Image size 2048x1536
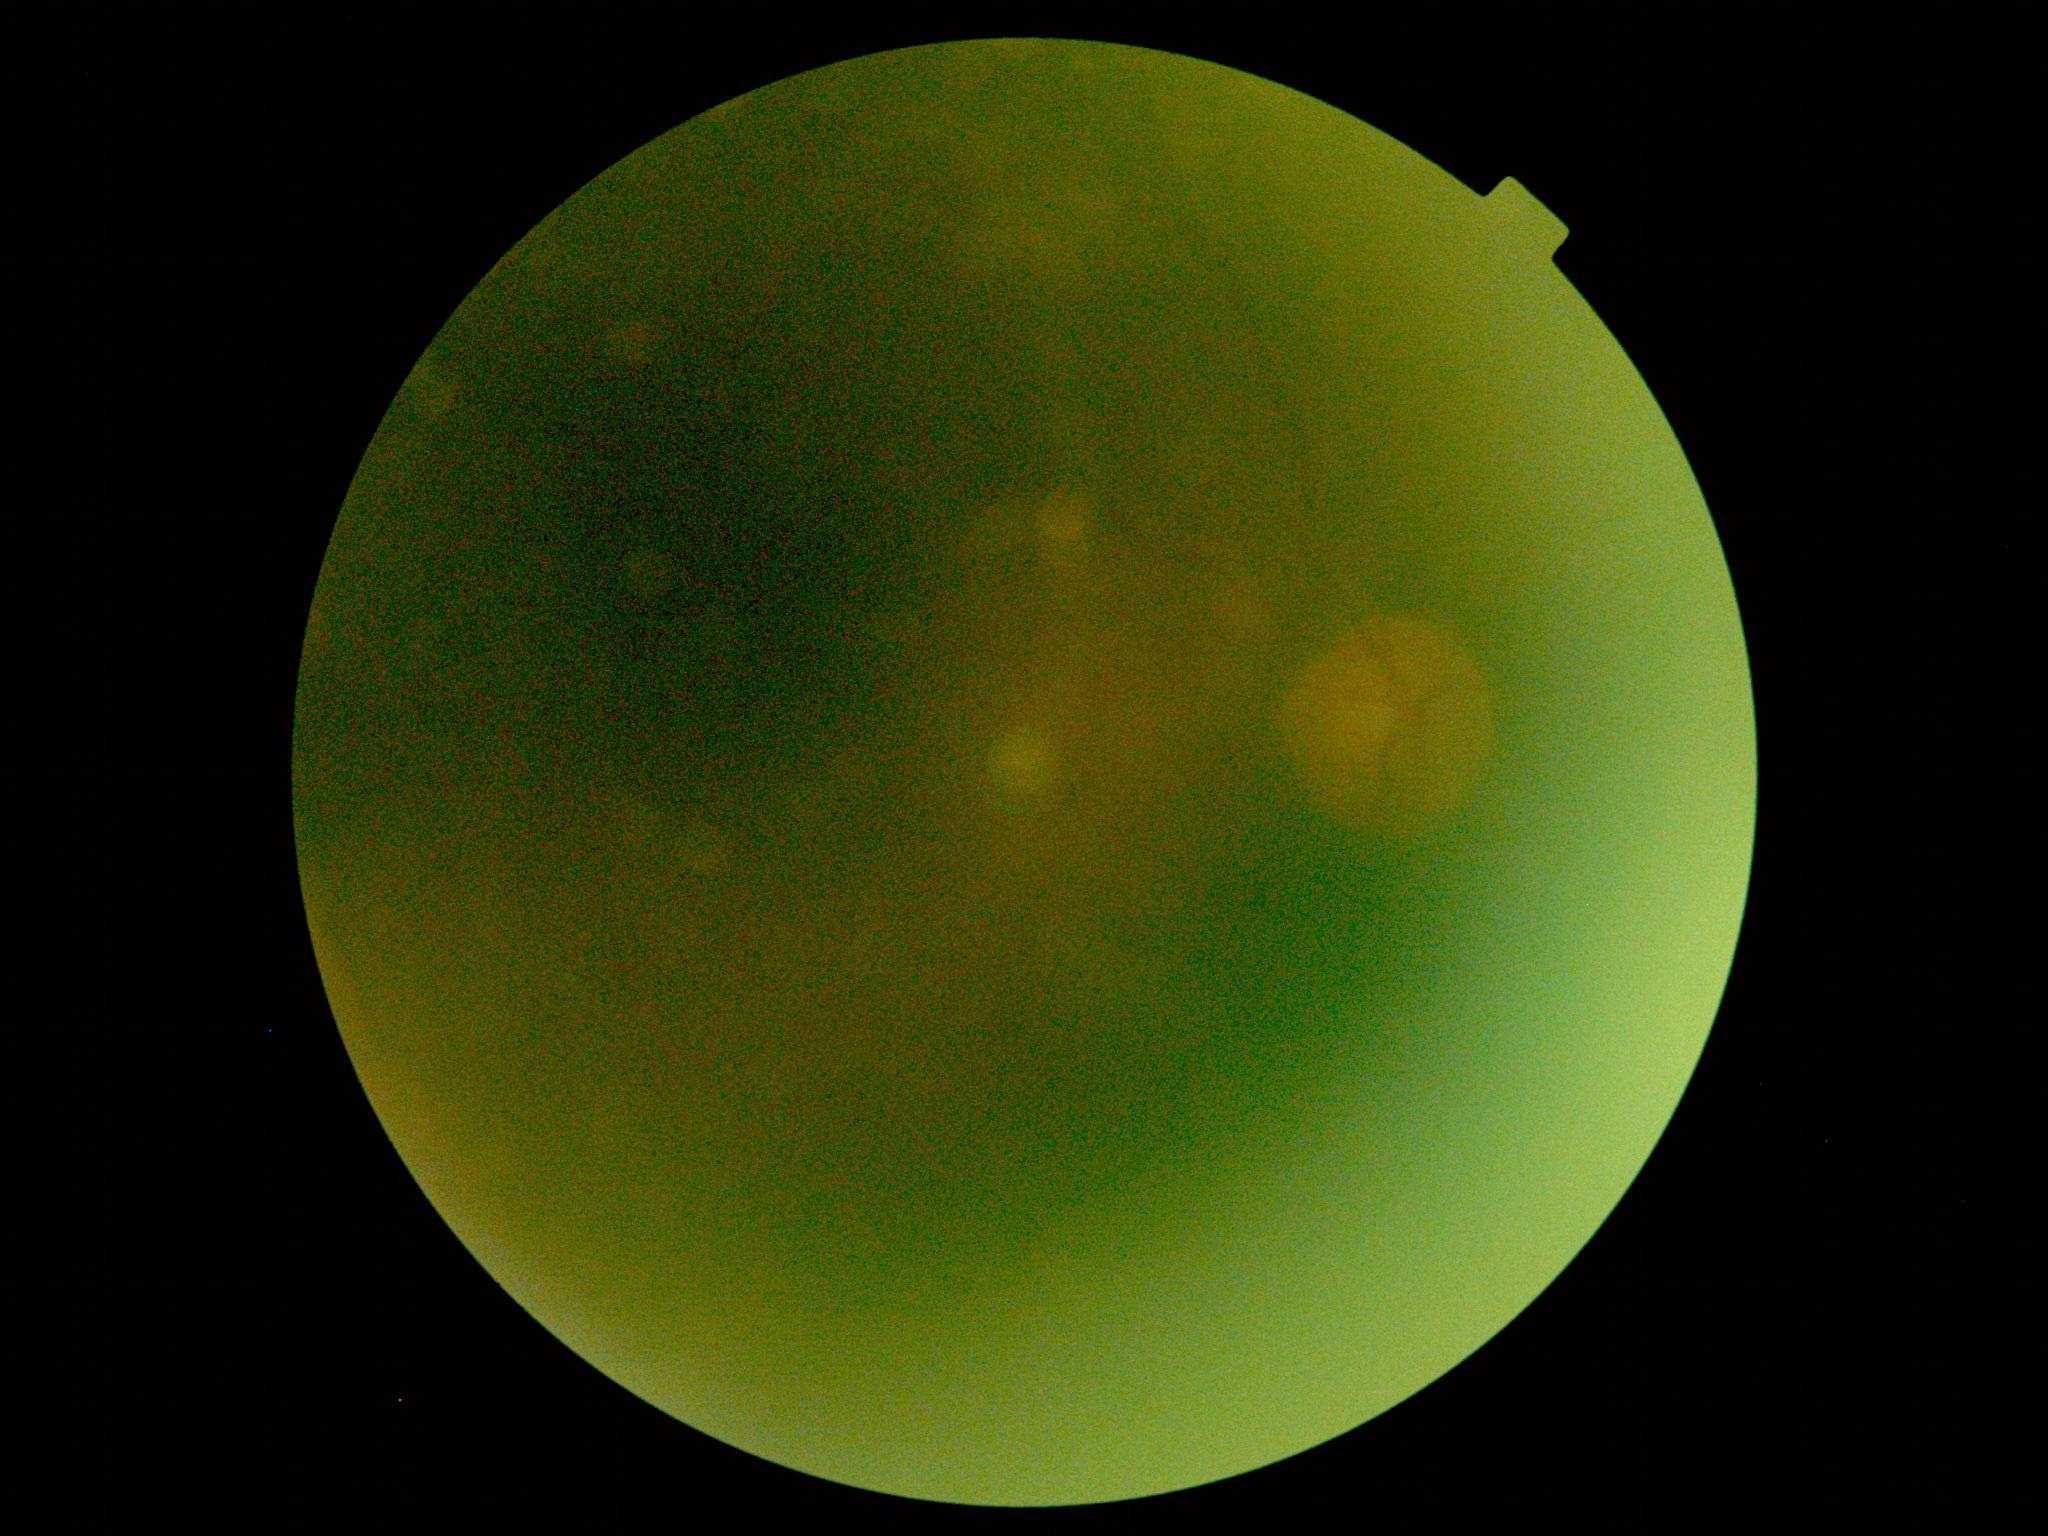

DR severity: ungradable due to poor image quality. Ungradable image — DR severity cannot be determined.